Infant wide-field retinal image
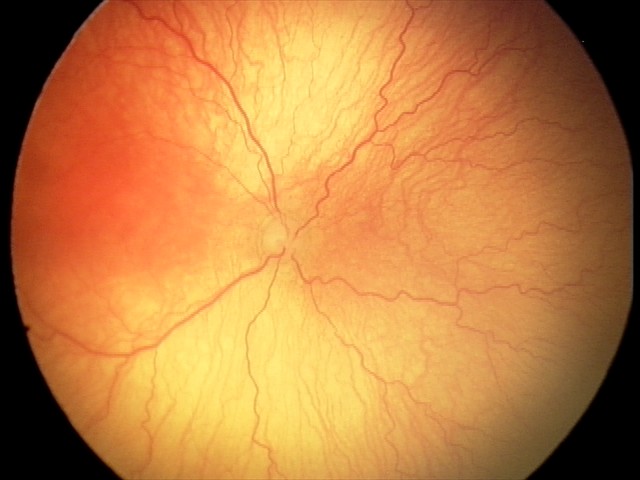
Examination diagnosed as aggressive retinopathy of prematurity (A-ROP).
With plus disease.